45° field of view
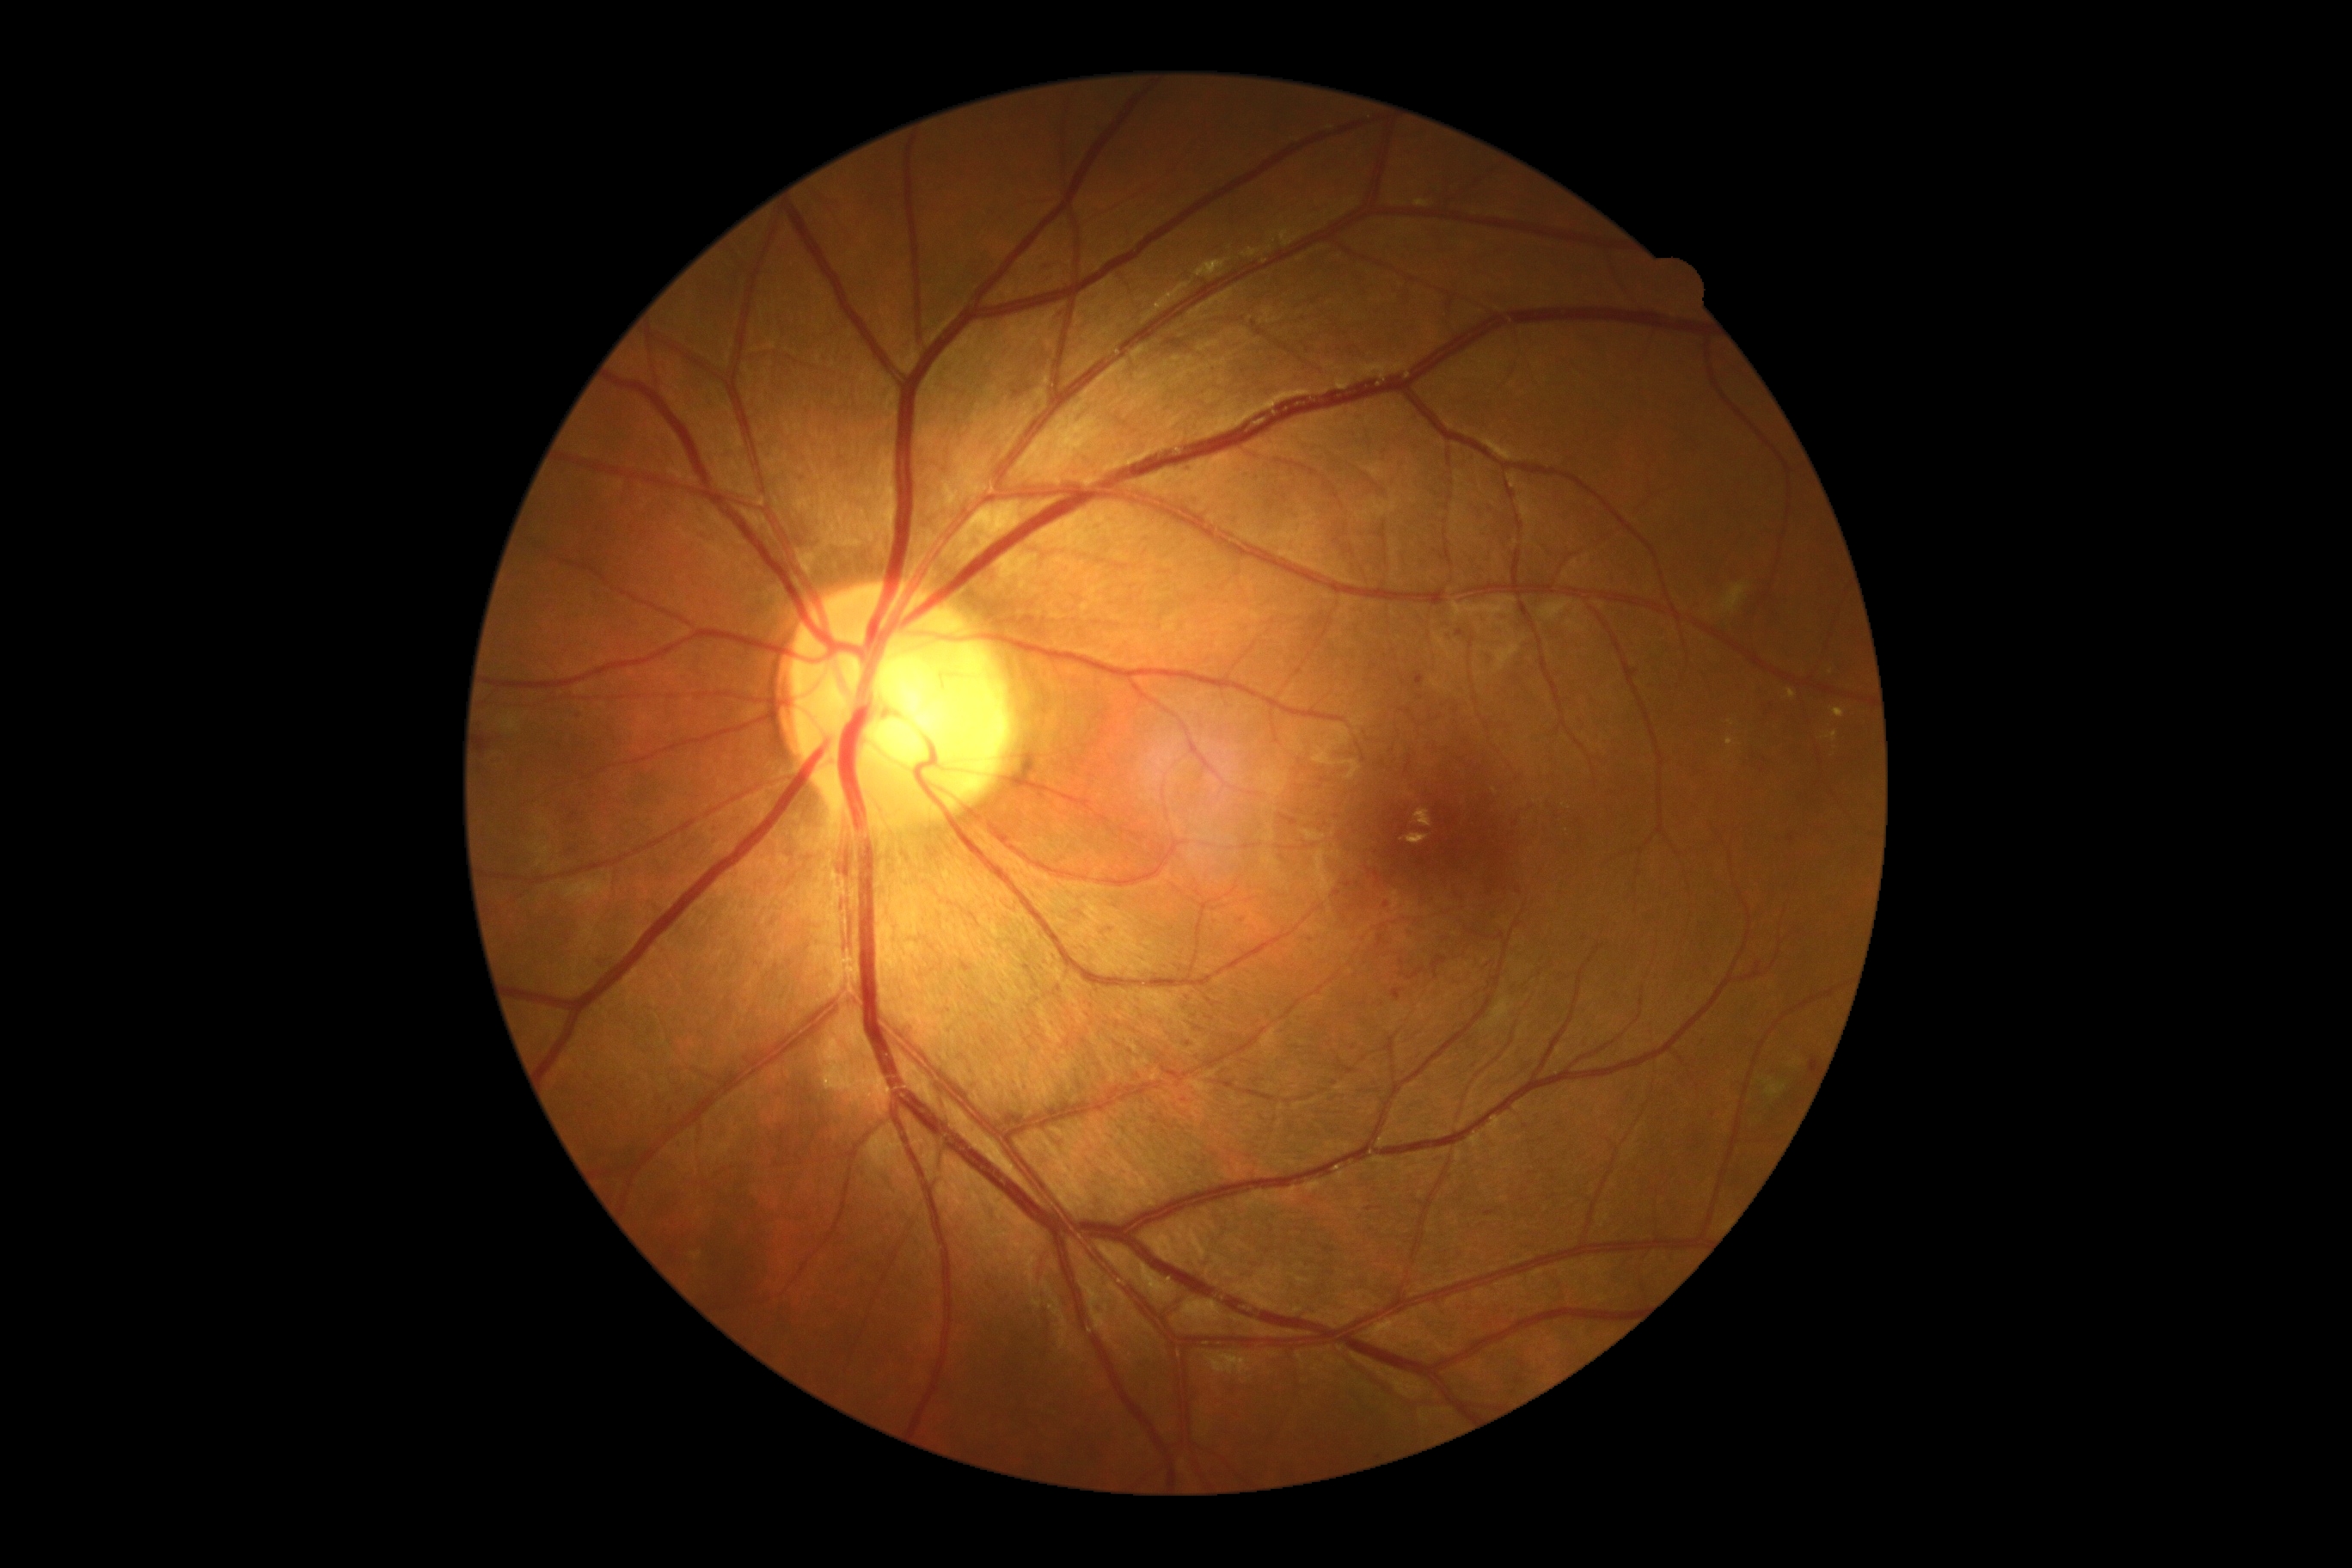 {"dr_grade": "grade 3 (severe NPDR)"}